Infant wide-field fundus photograph · captured with the Phoenix ICON (100° field of view) — 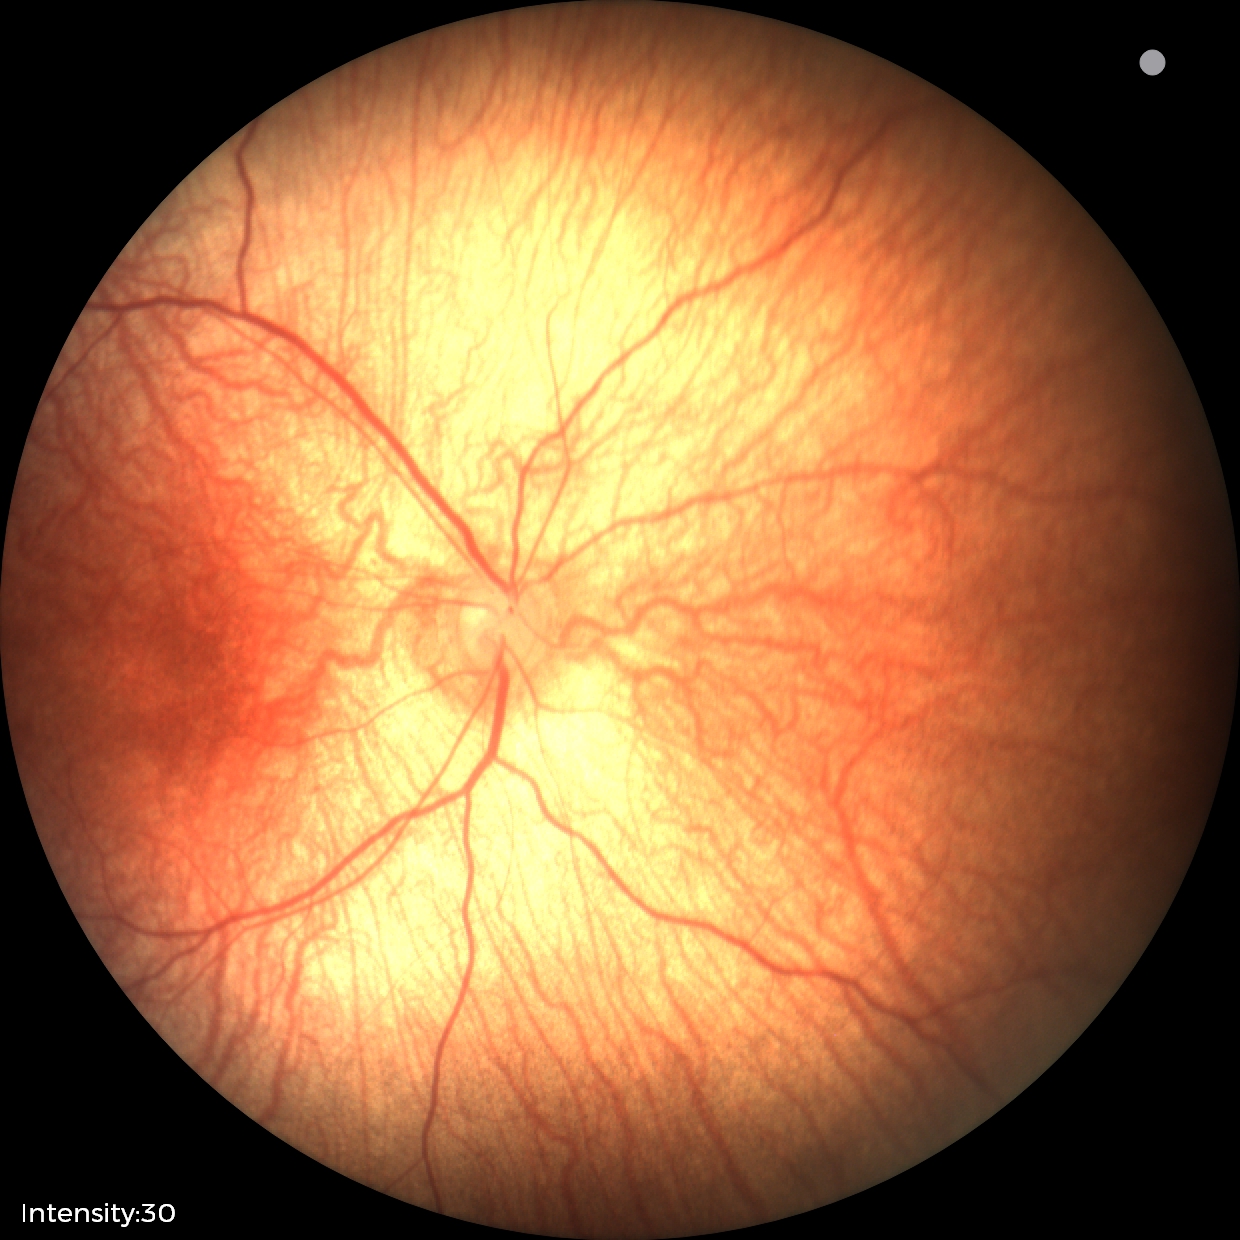
Finding = no pathology identified.